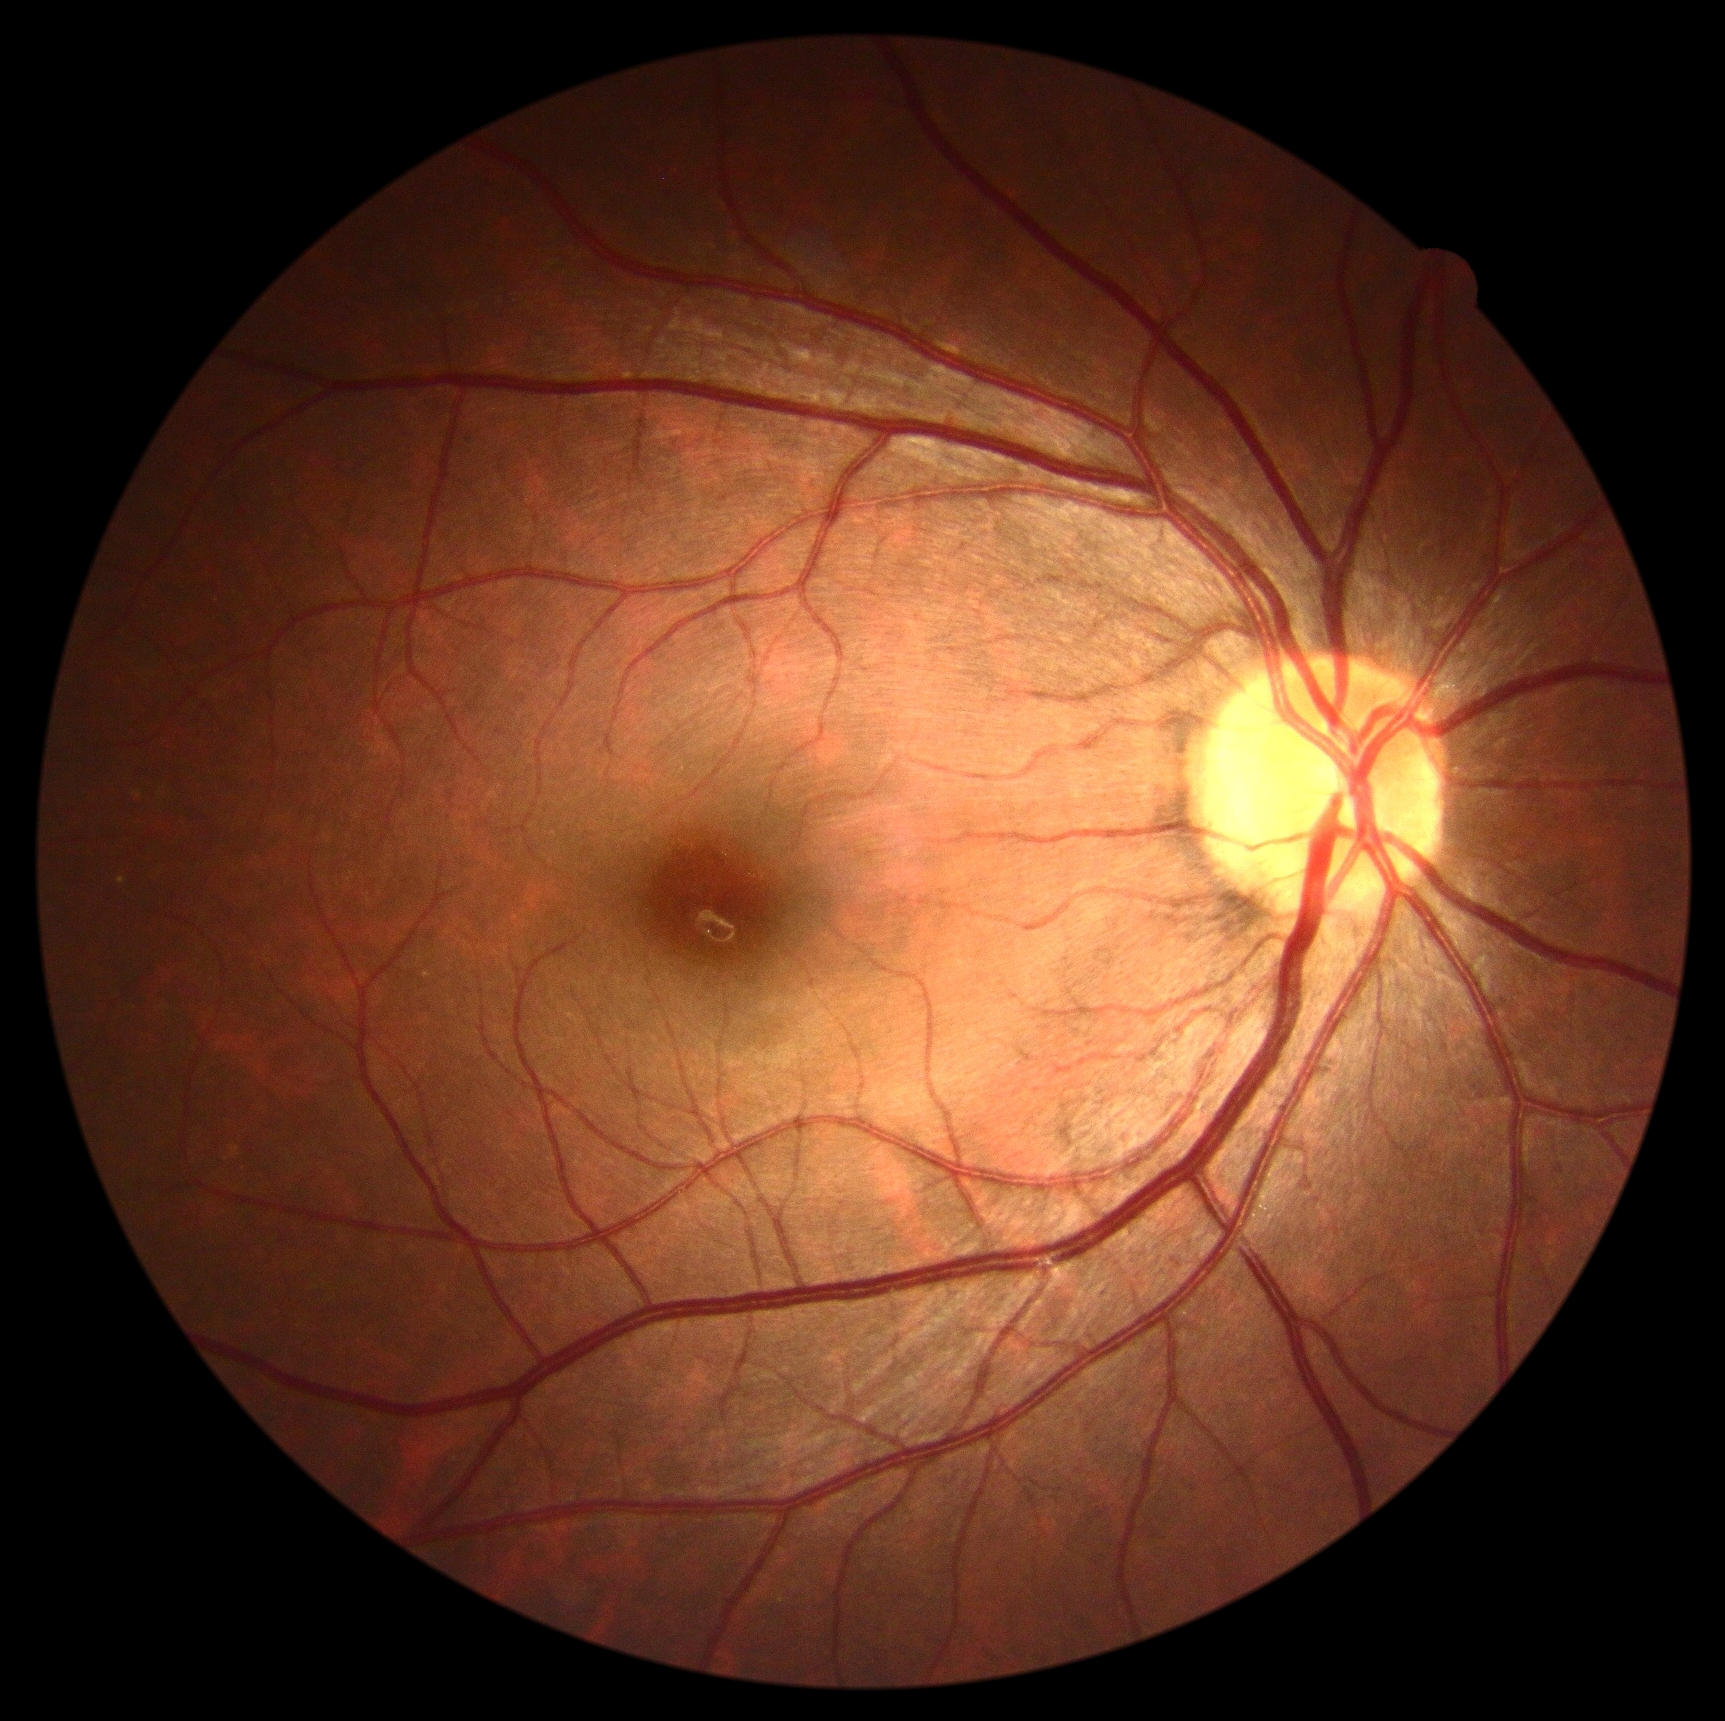
Findings:
* DR severity: 0 — no visible signs of diabetic retinopathy
* DR impression: no DR findings